CFP, modified Davis classification — 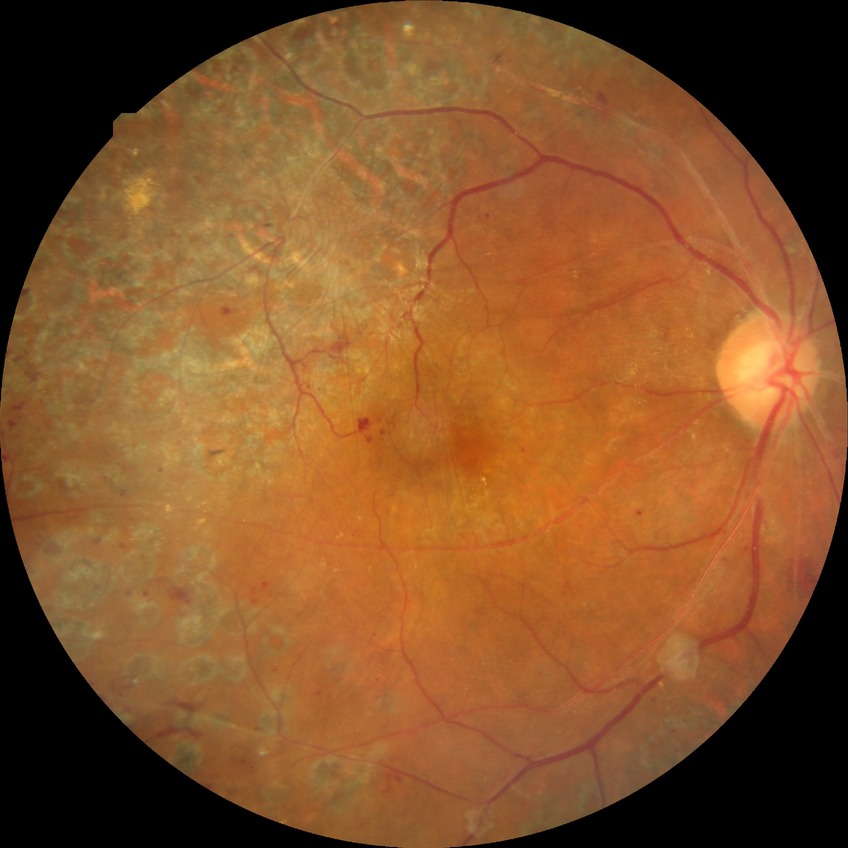

– modified Davis grade — PDR